Captured on a Topcon TRC-NW8 fundus camera · 1932 x 1932 pixels · dilated-pupil acquisition:
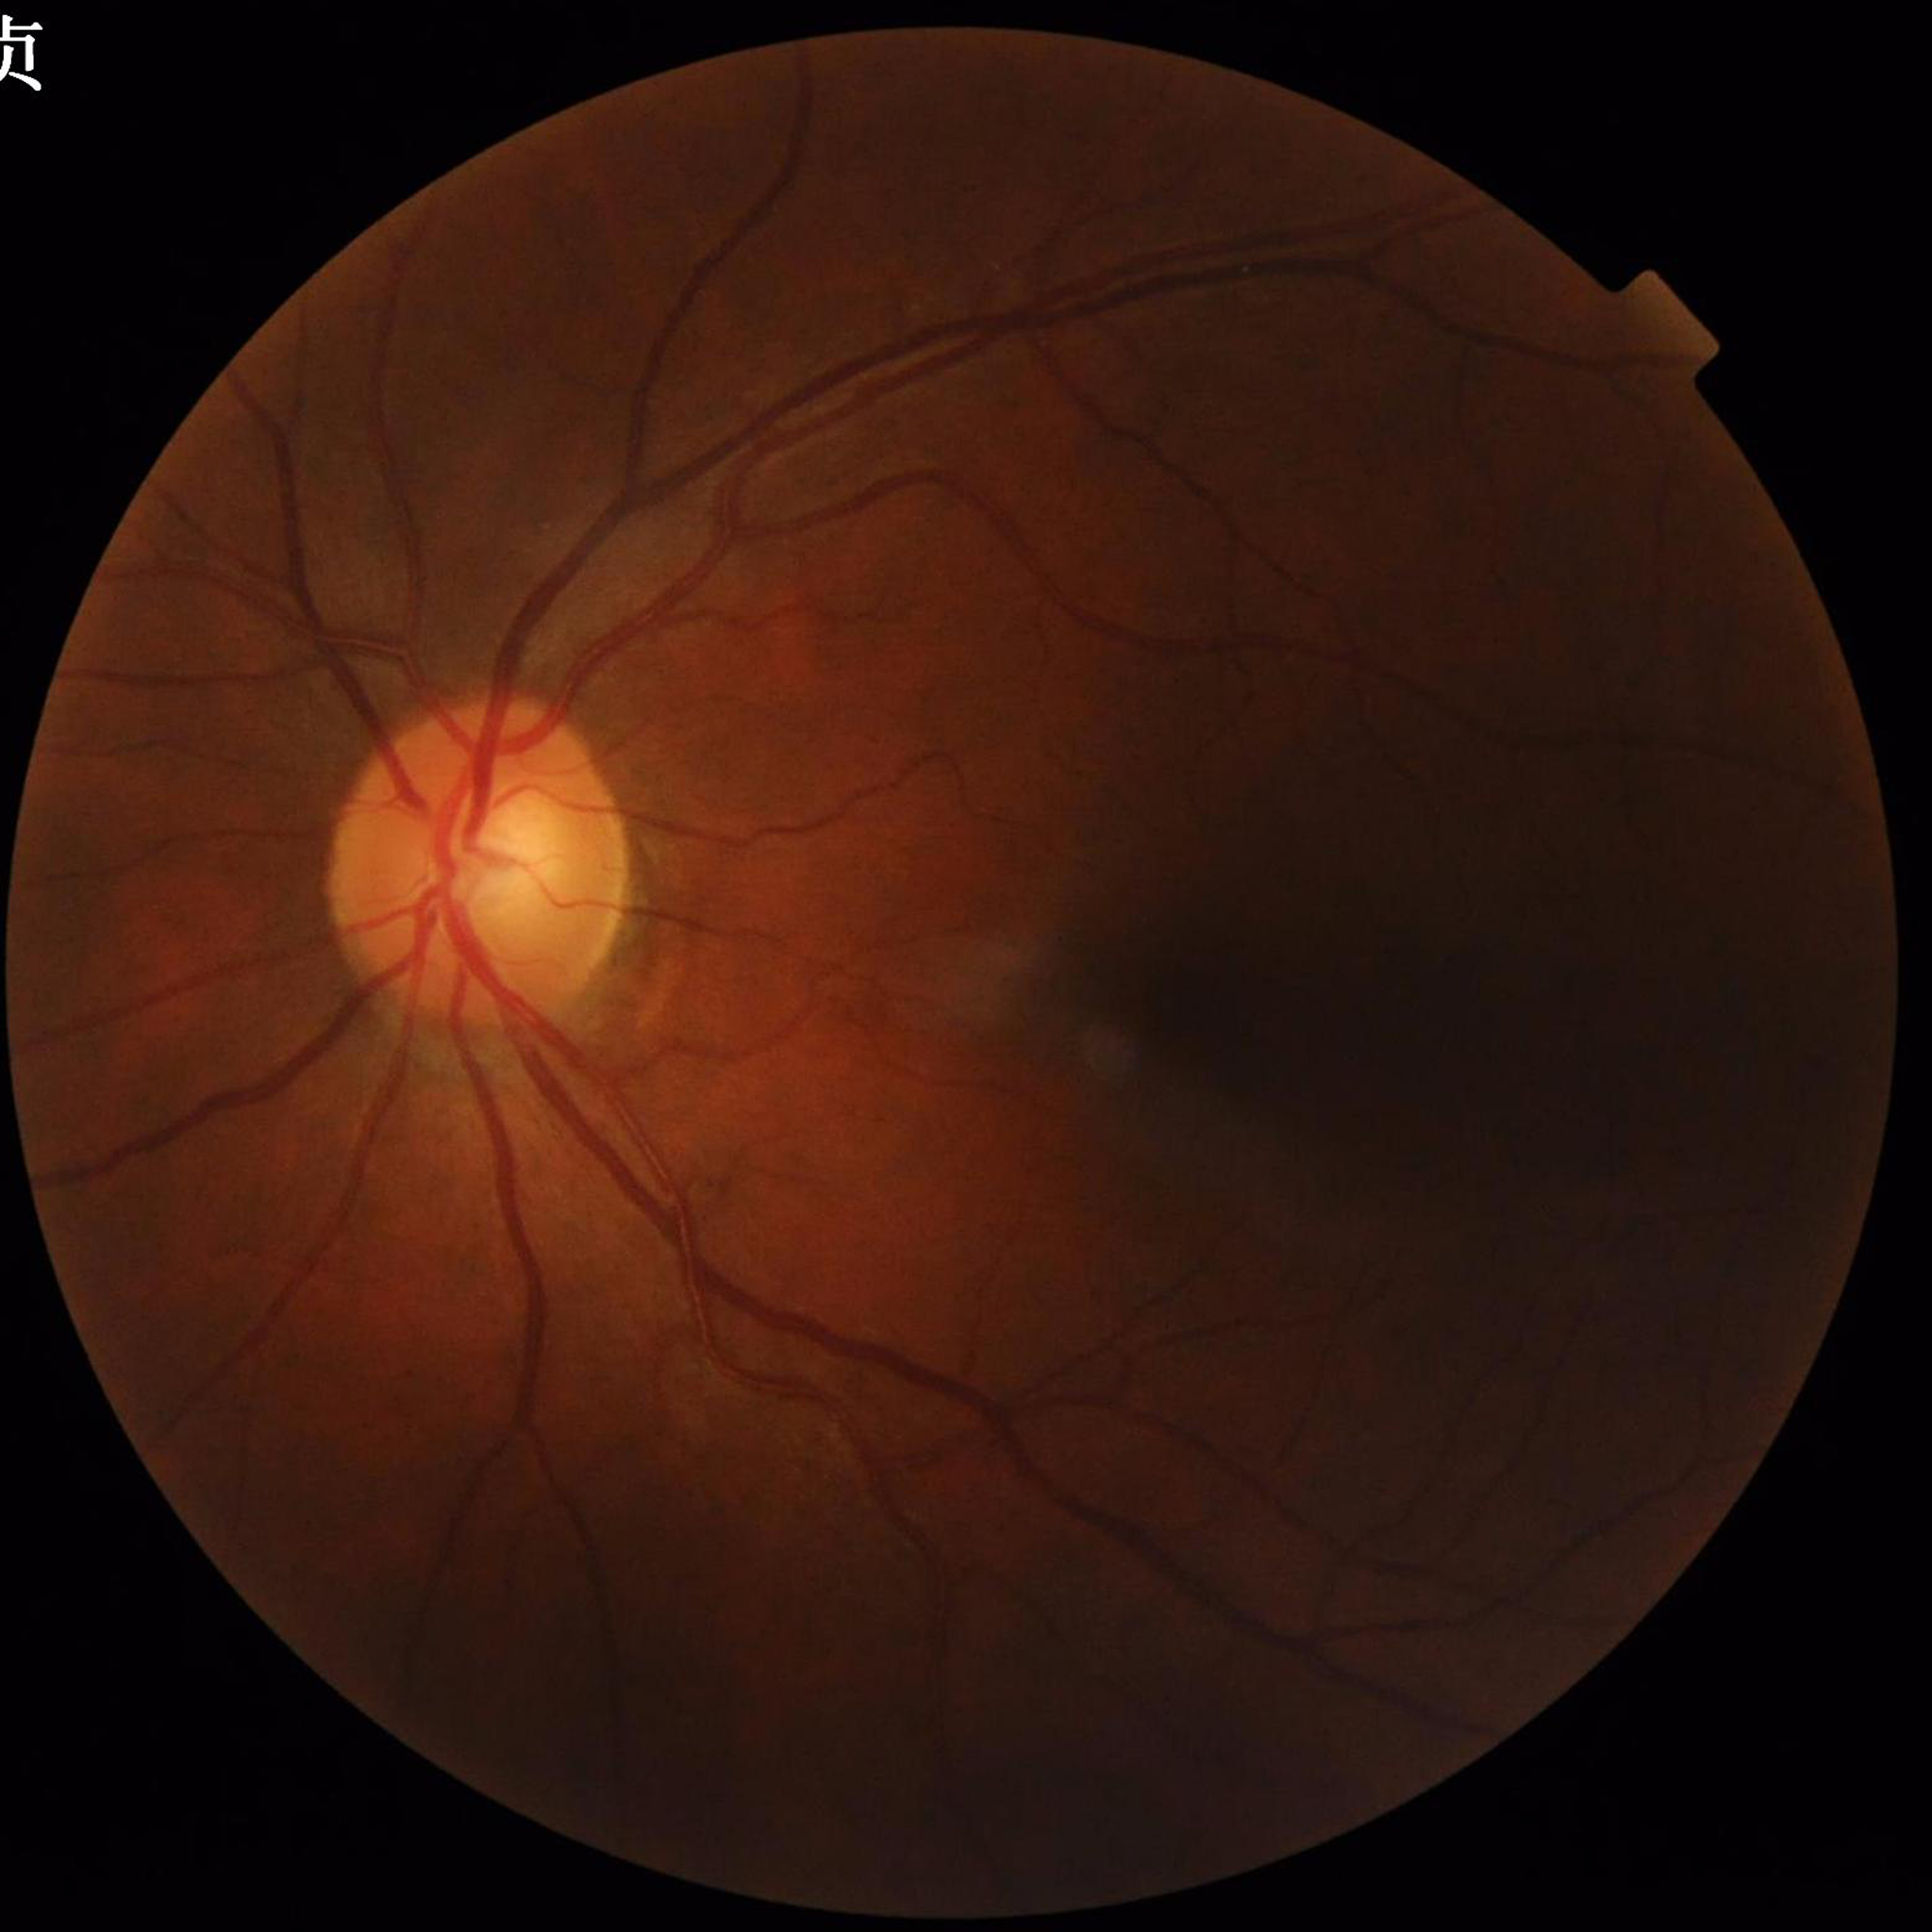 Quality: contrast adequate, no blur, illumination/color distortion present. No signs of AMD, diabetic retinopathy, or glaucoma.